45° field of view · 848x848px:
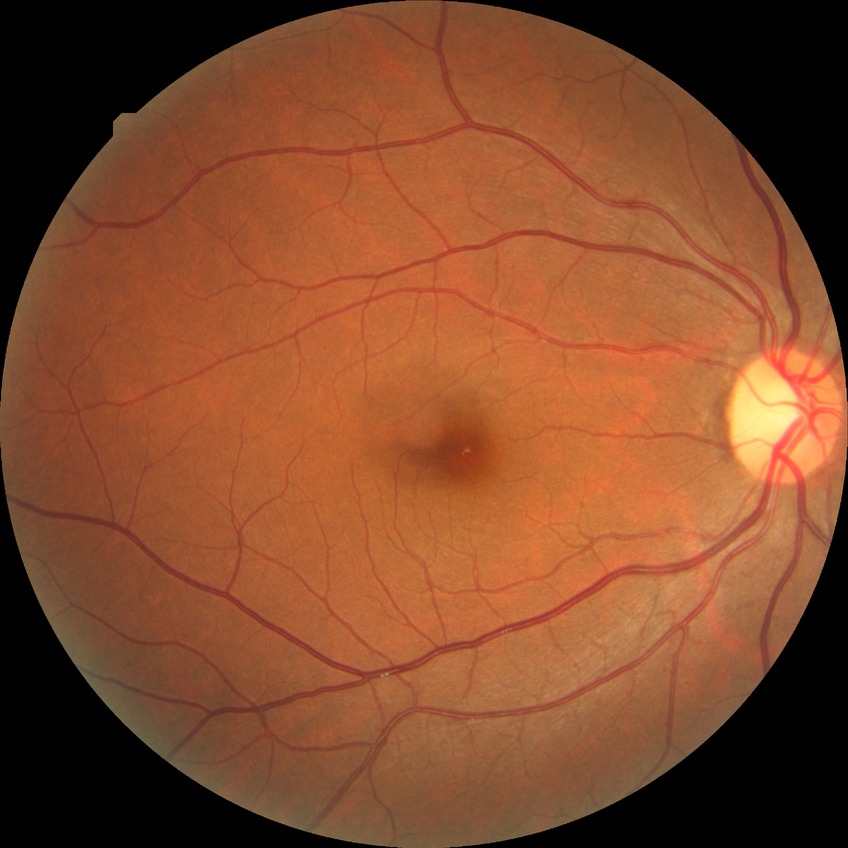 Diabetic retinopathy (DR) is NDR (no diabetic retinopathy).